Pediatric retinal photograph (wide-field); 640x480 — 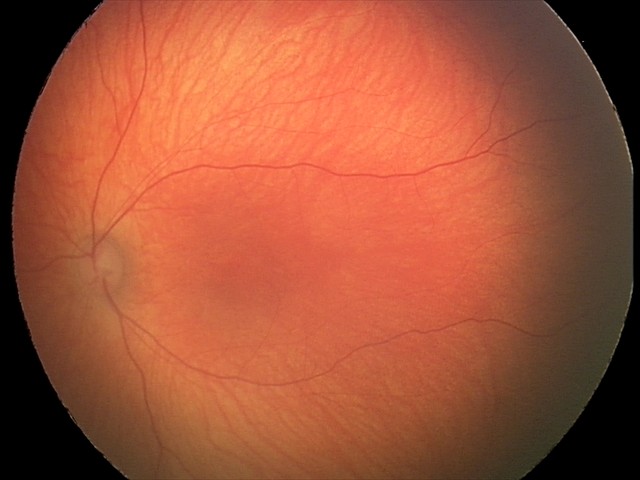
Assessment: normal fundus examination.